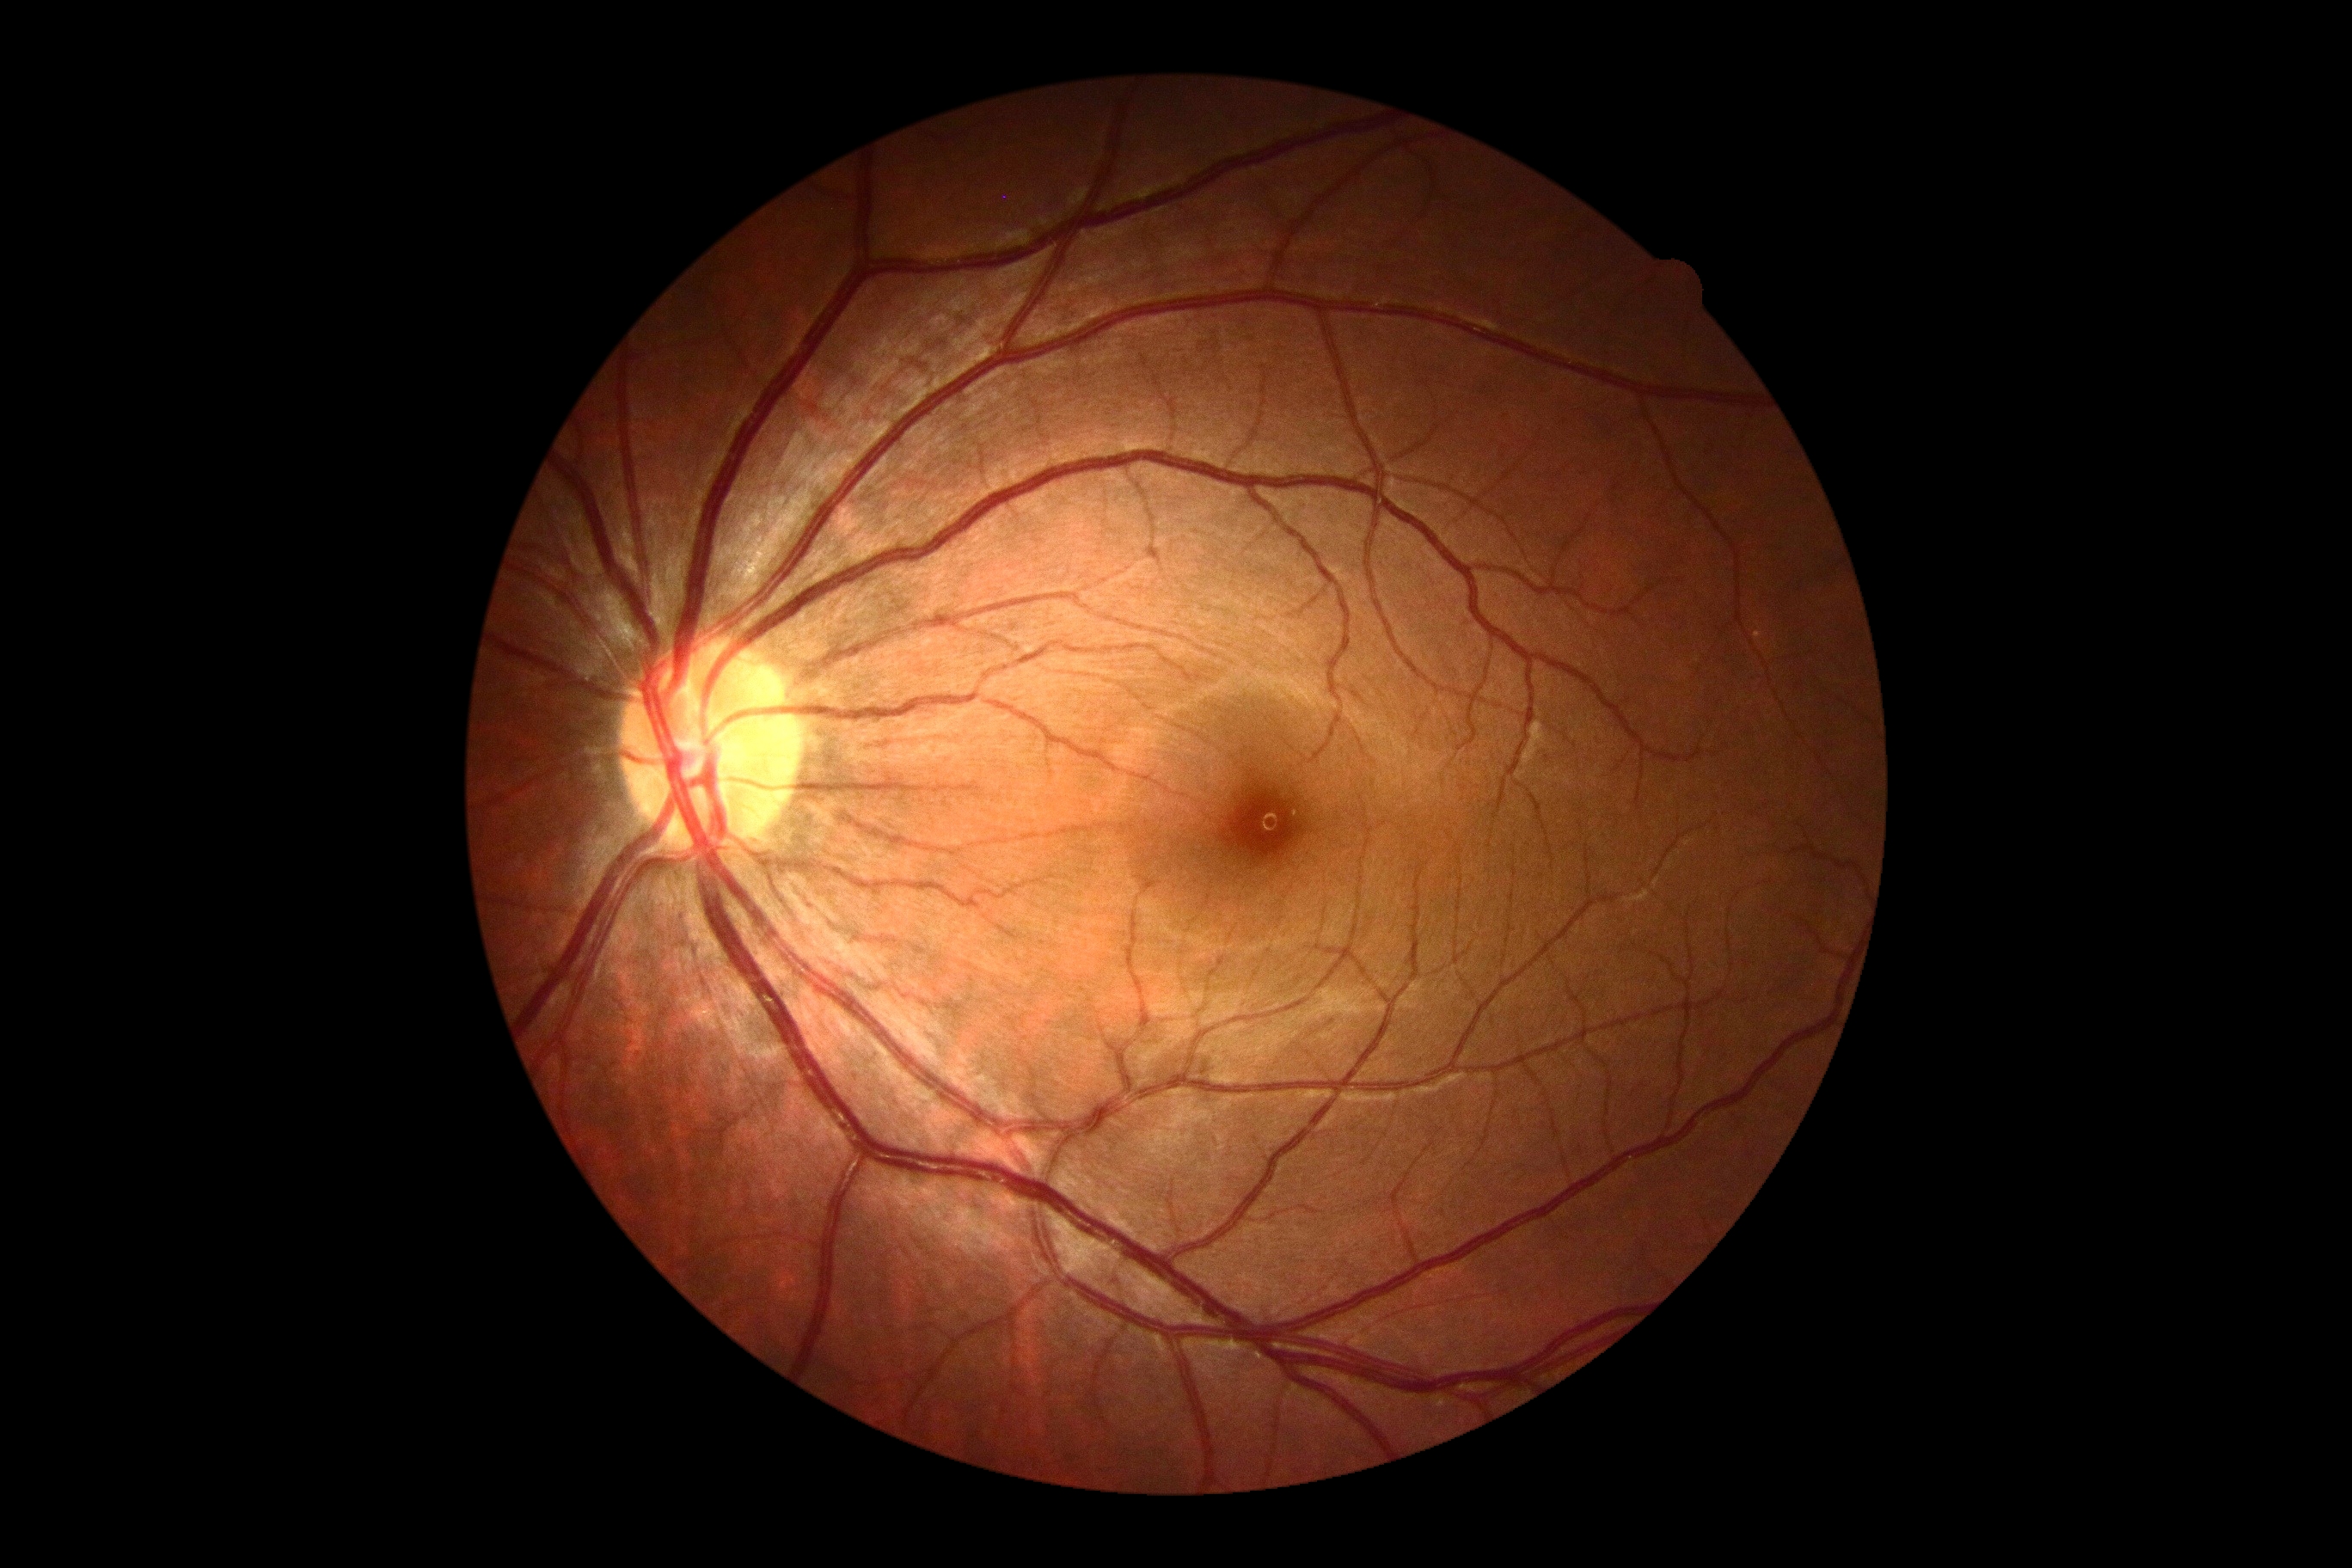
{"dr_grade": "grade 0"}